Refraction: +0.75 -0.75 x 95. Gender: F. Image size 2212x1661. FOV: 30 degrees. Retinal fundus photograph. Axial length (AL): 23.24 mm. Non-mydriatic. 34-year-old patient.
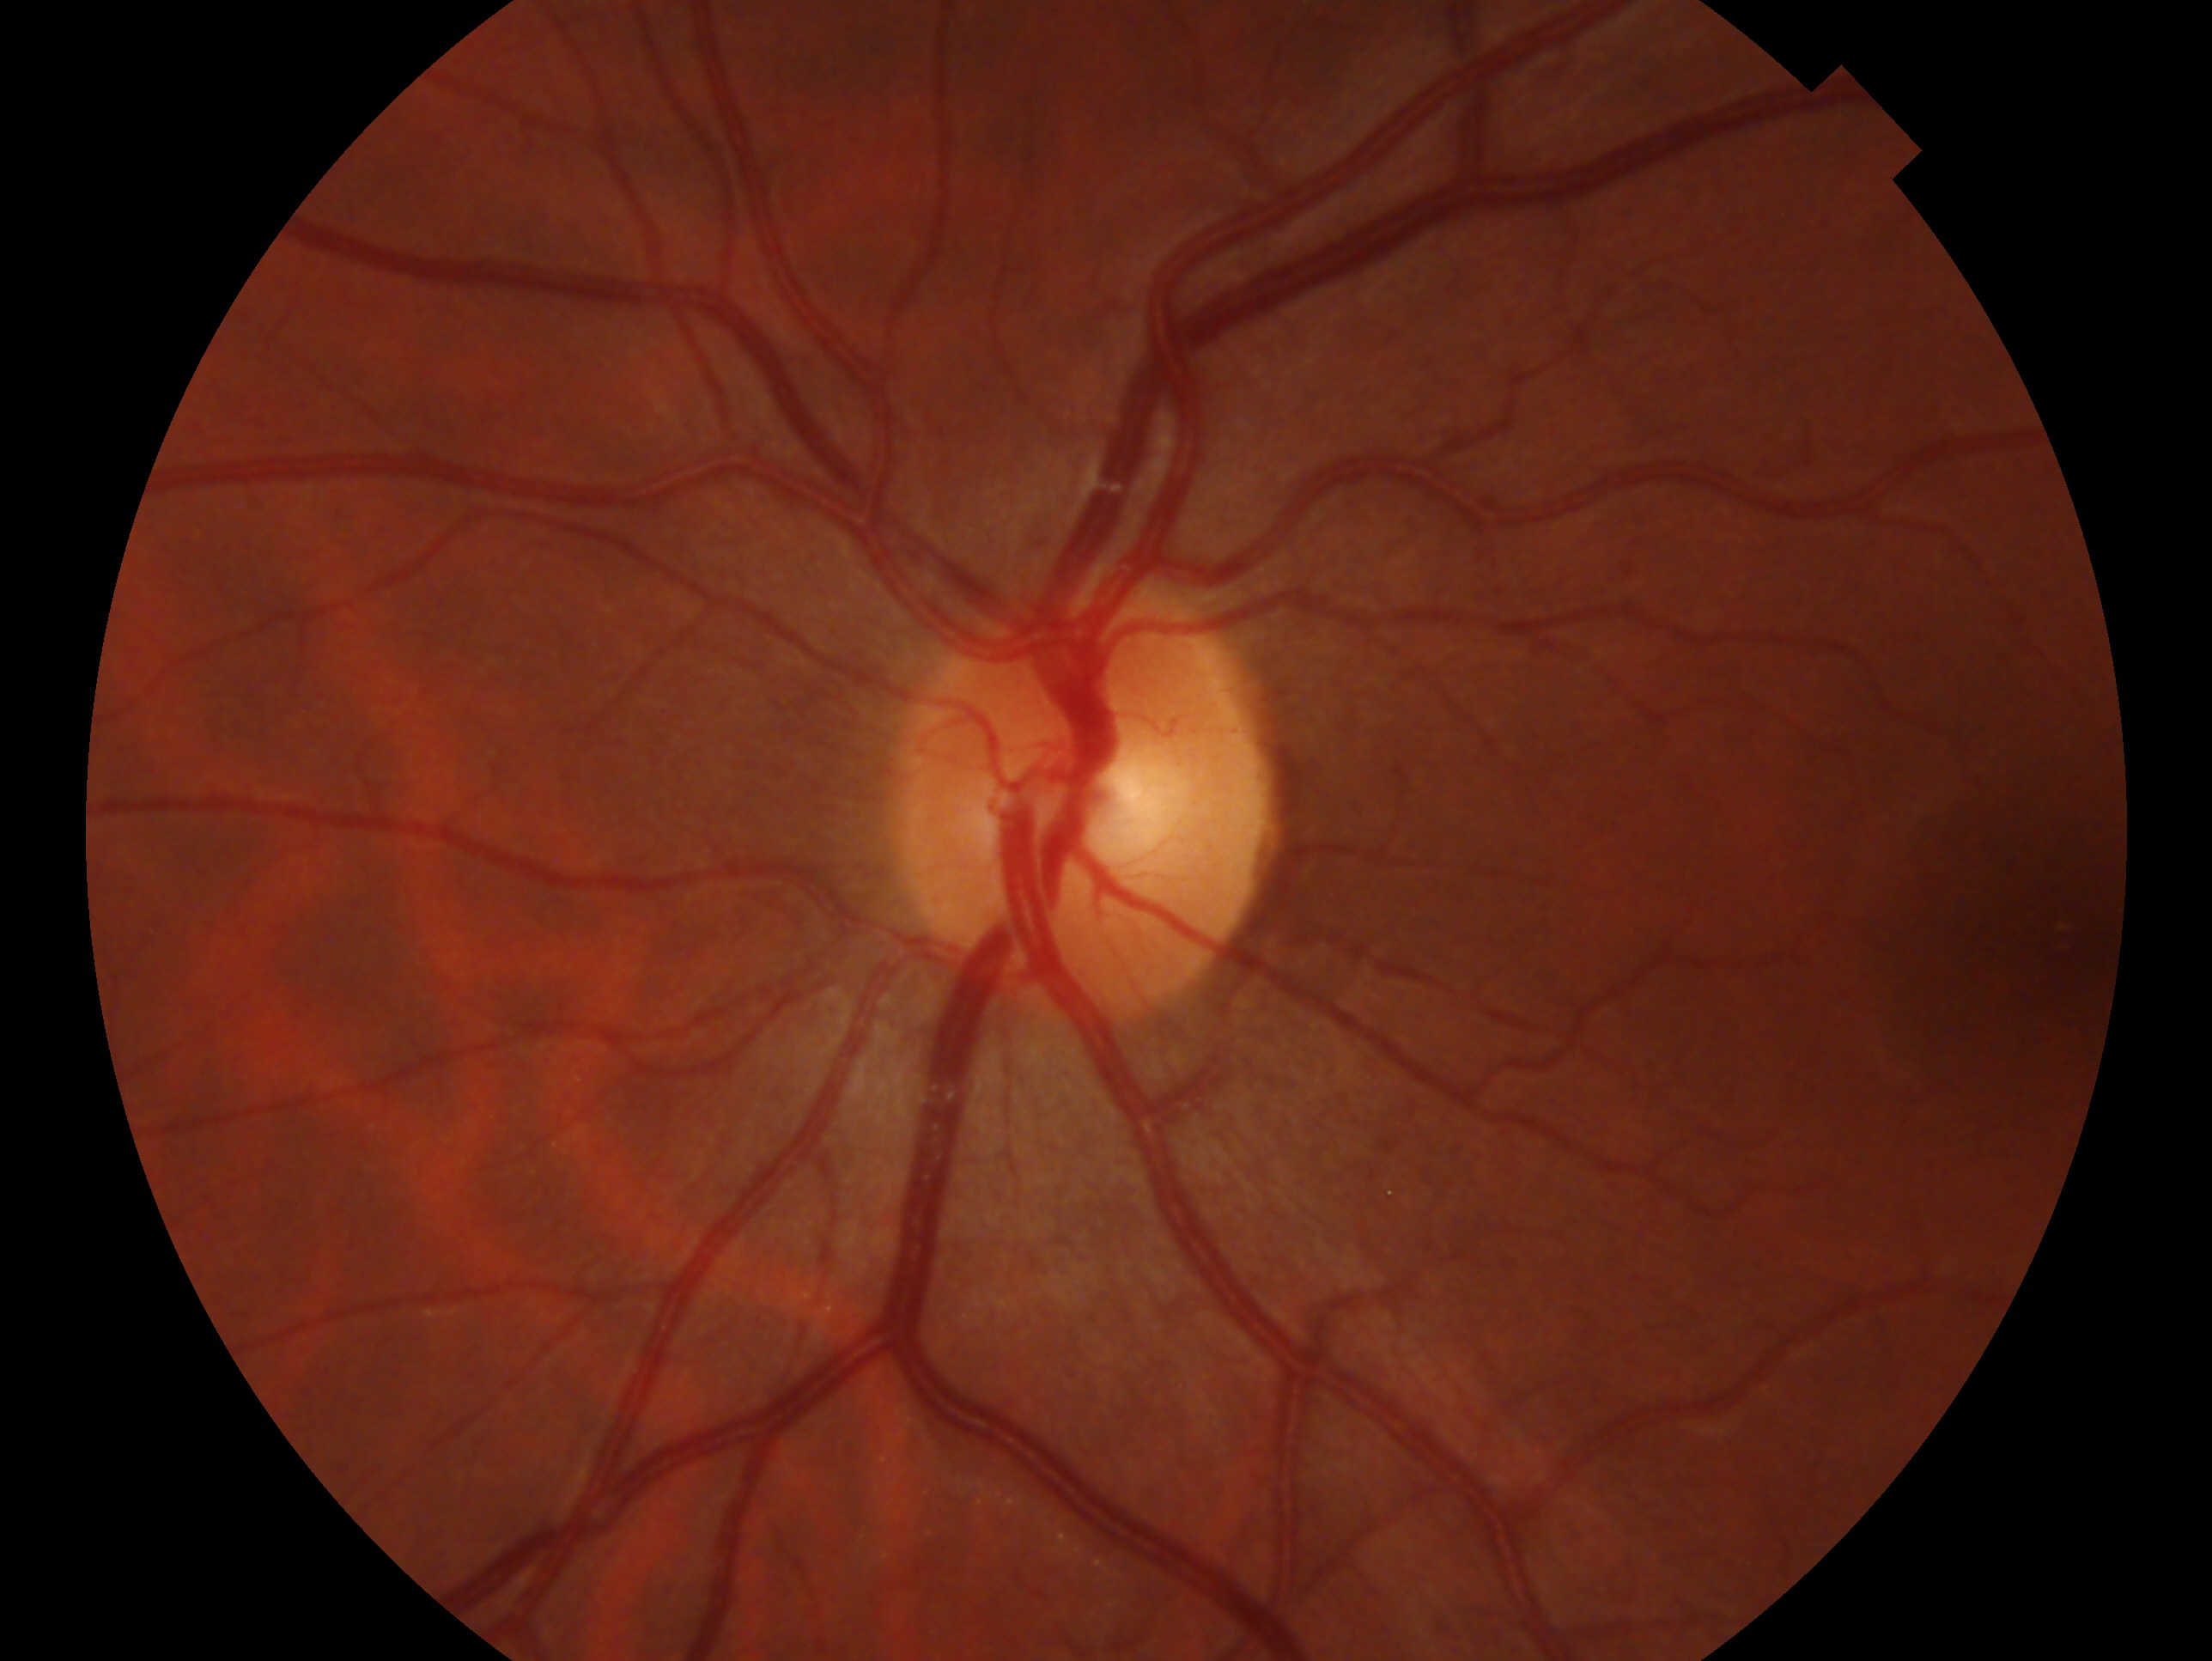 The image shows the left eye. Glaucoma diagnosis: no glaucomatous findings.